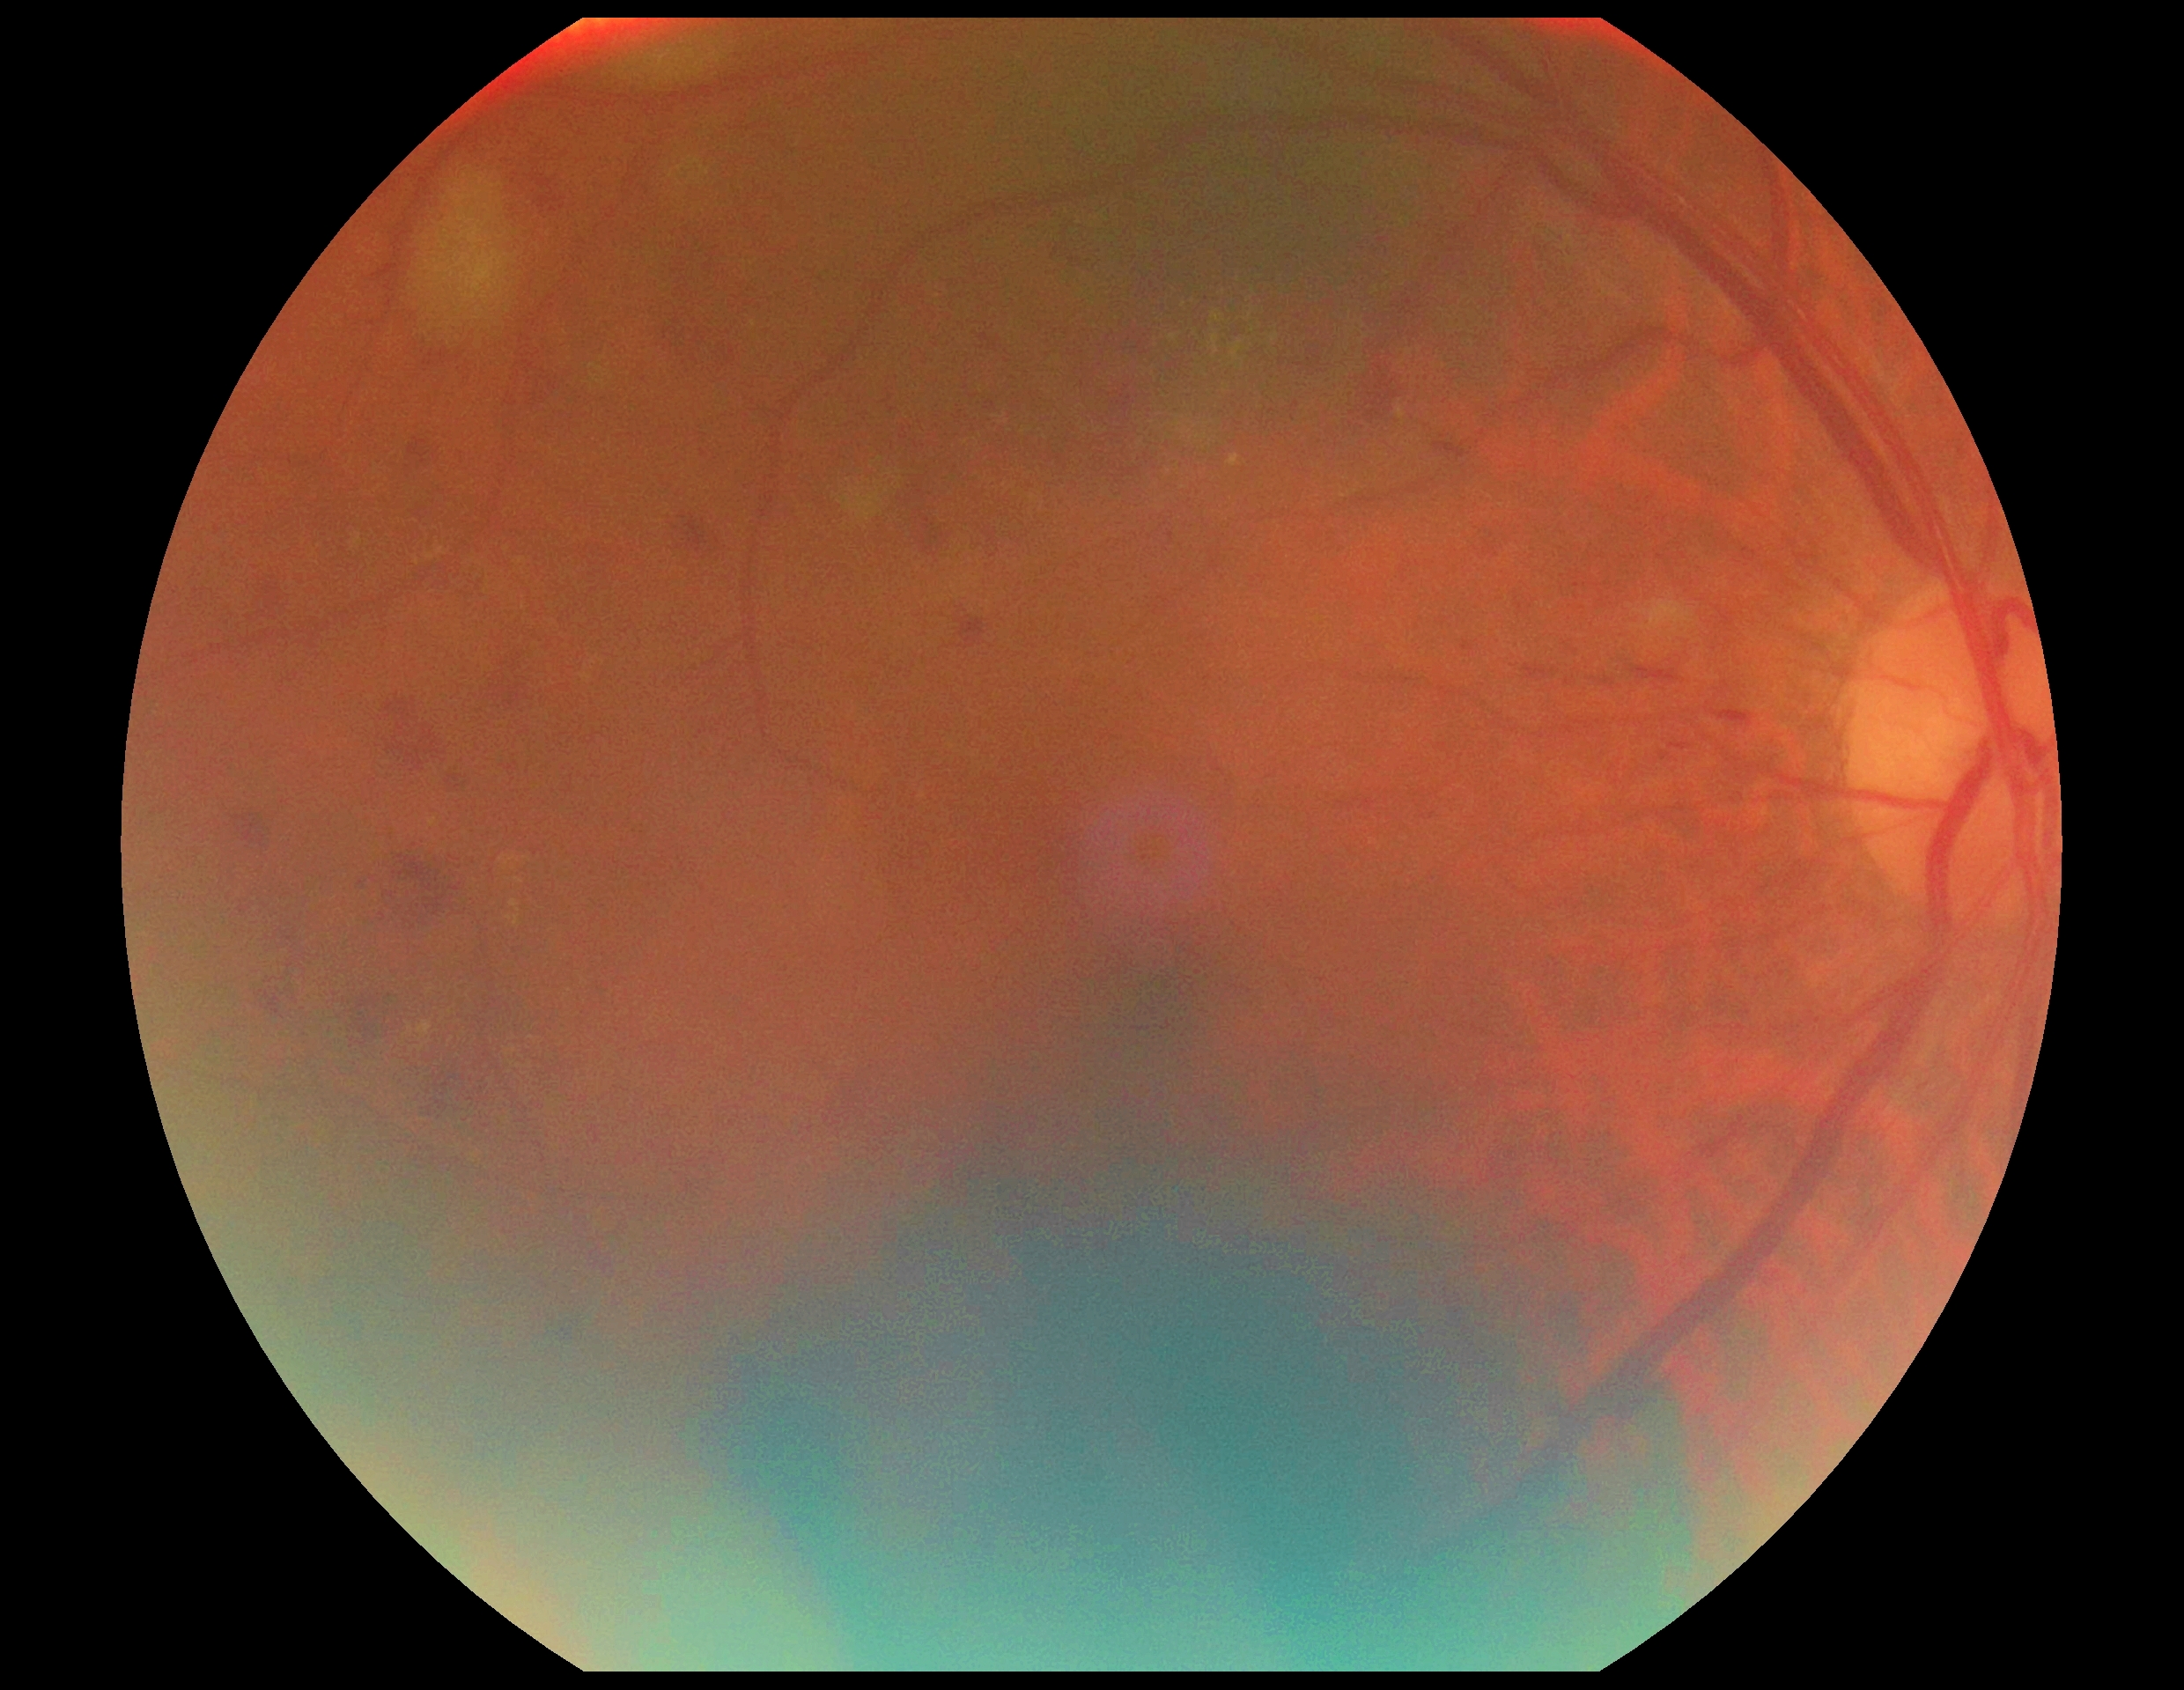

Diabetic retinopathy (DR): grade 2 (moderate NPDR).